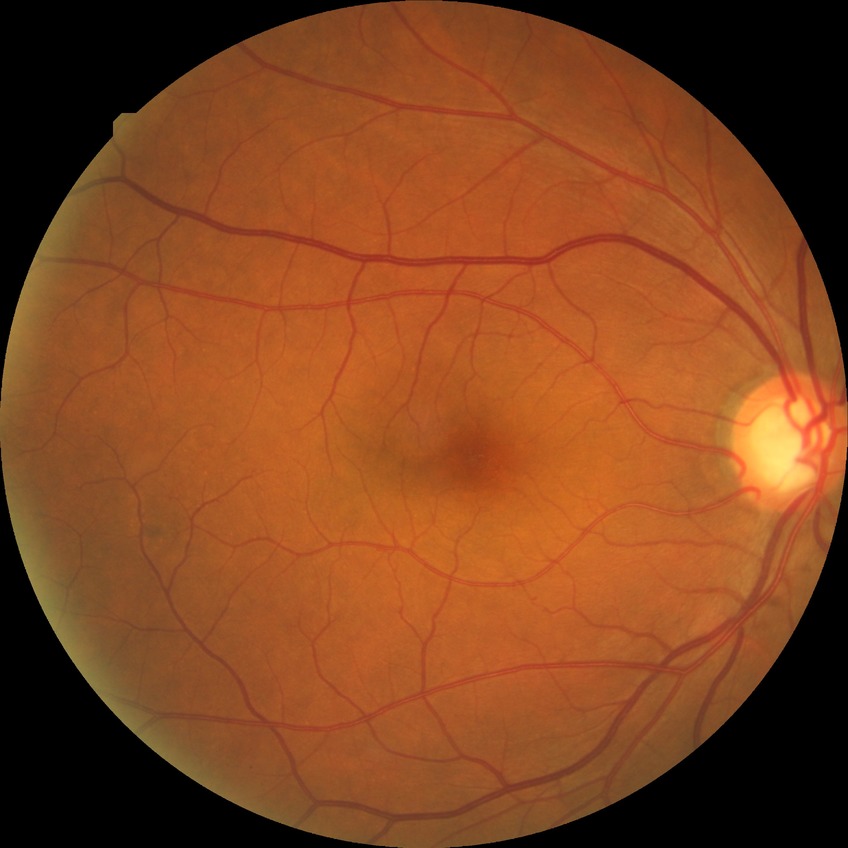

Diabetic retinopathy stage is no diabetic retinopathy.